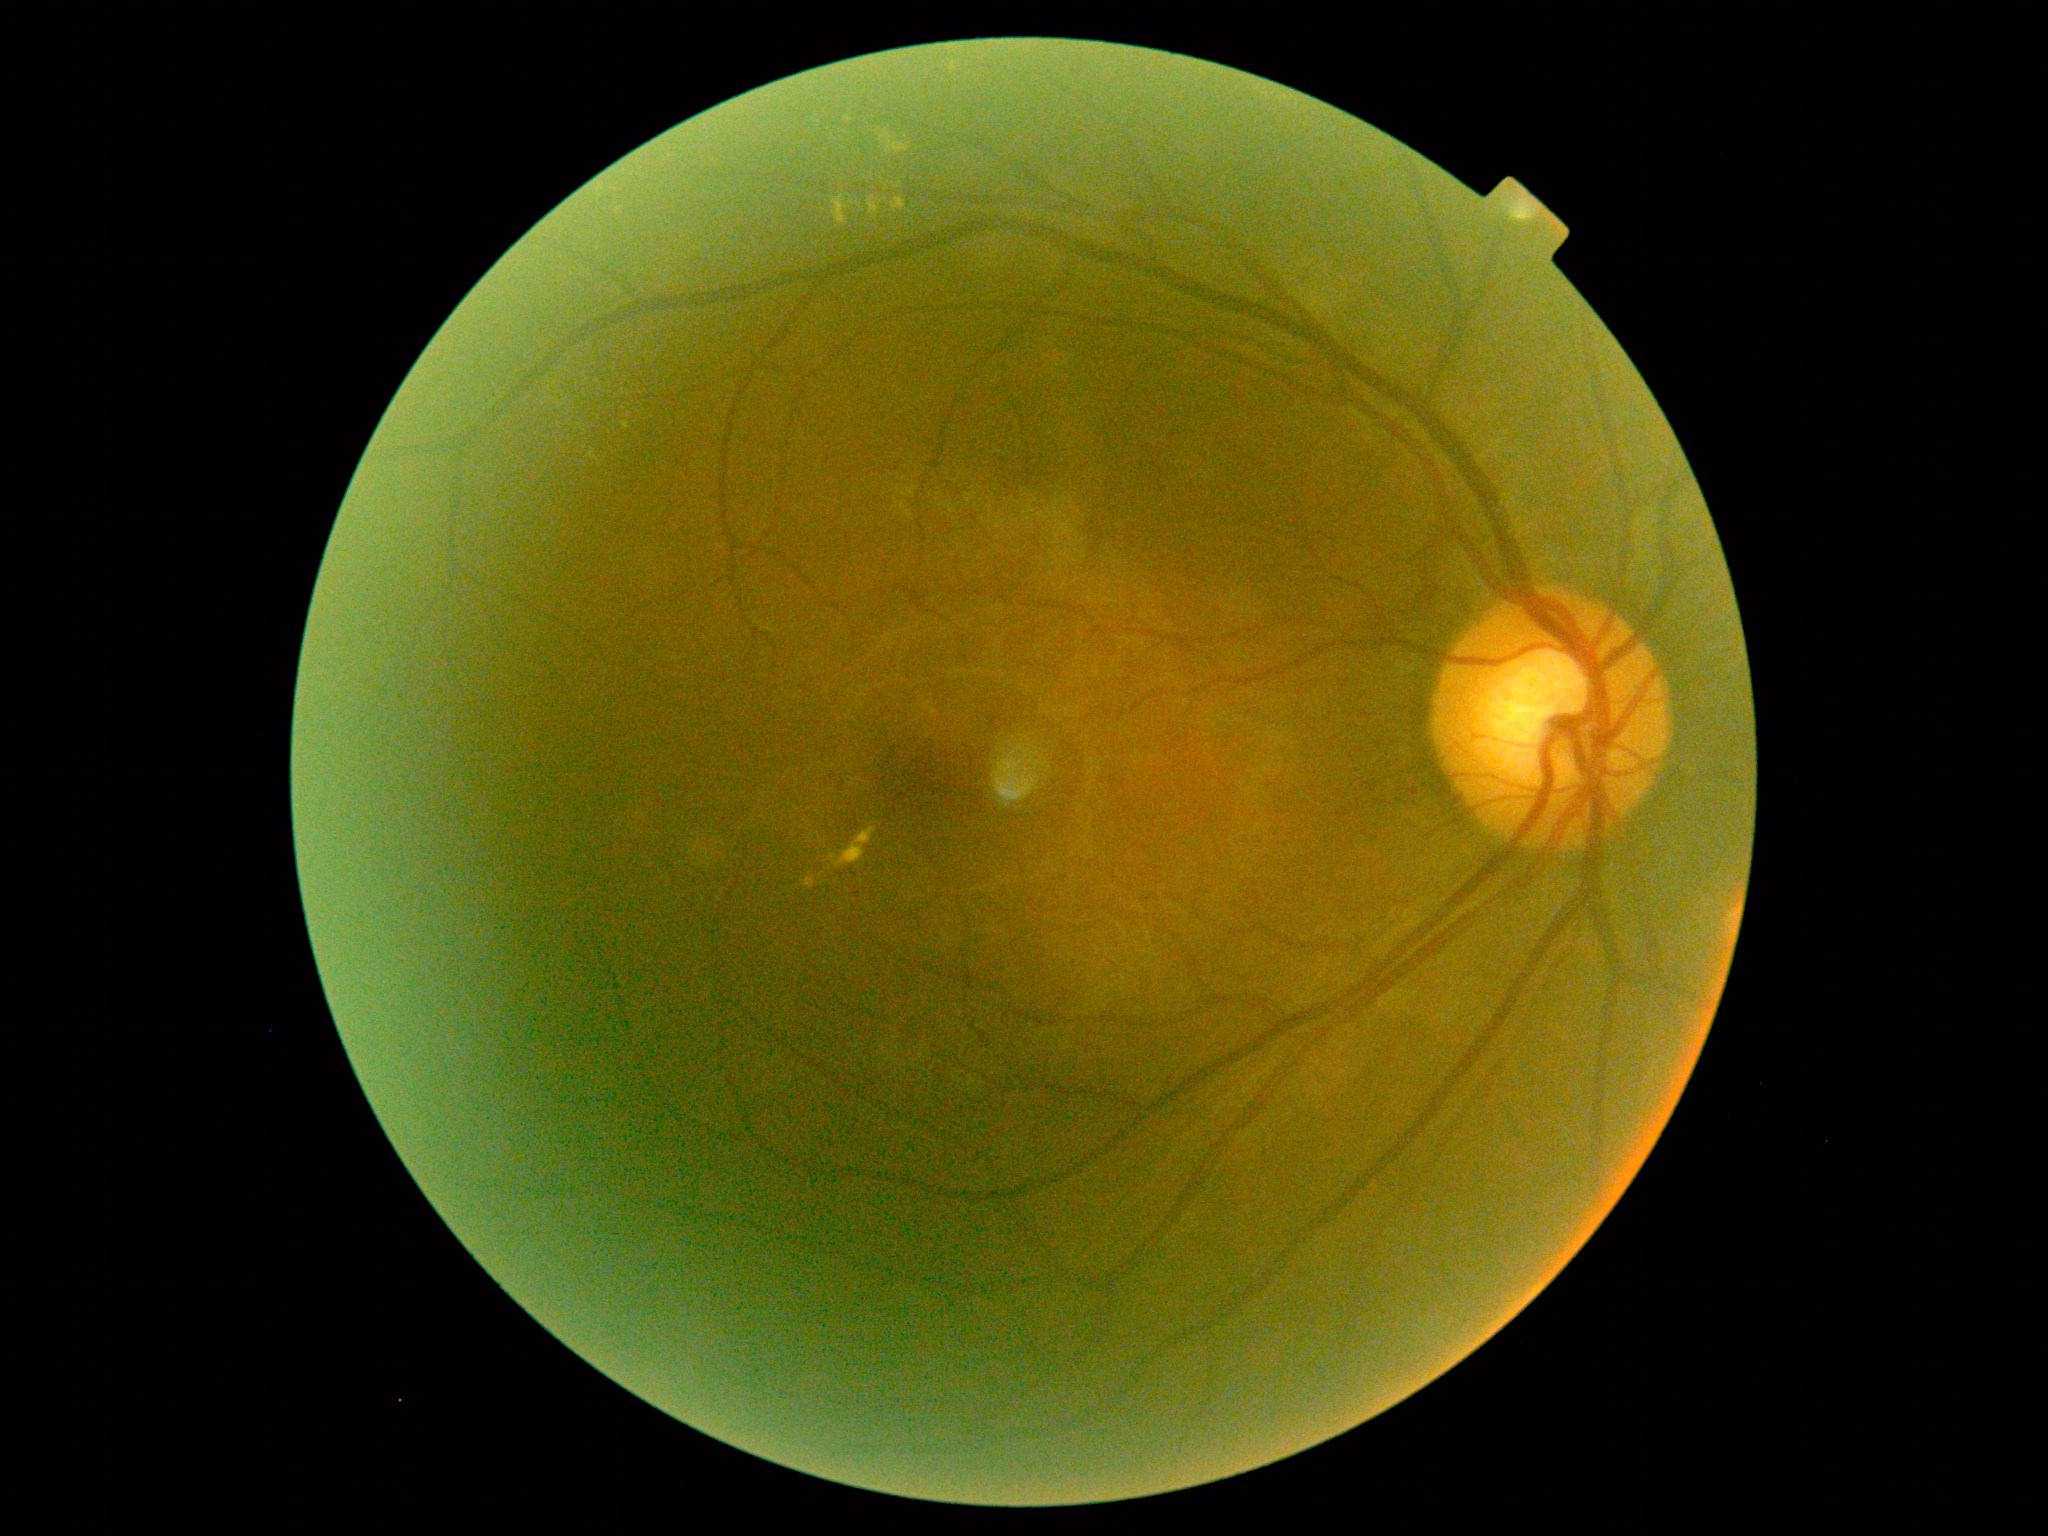
DR grade: 2 (moderate NPDR).